45° FOV: 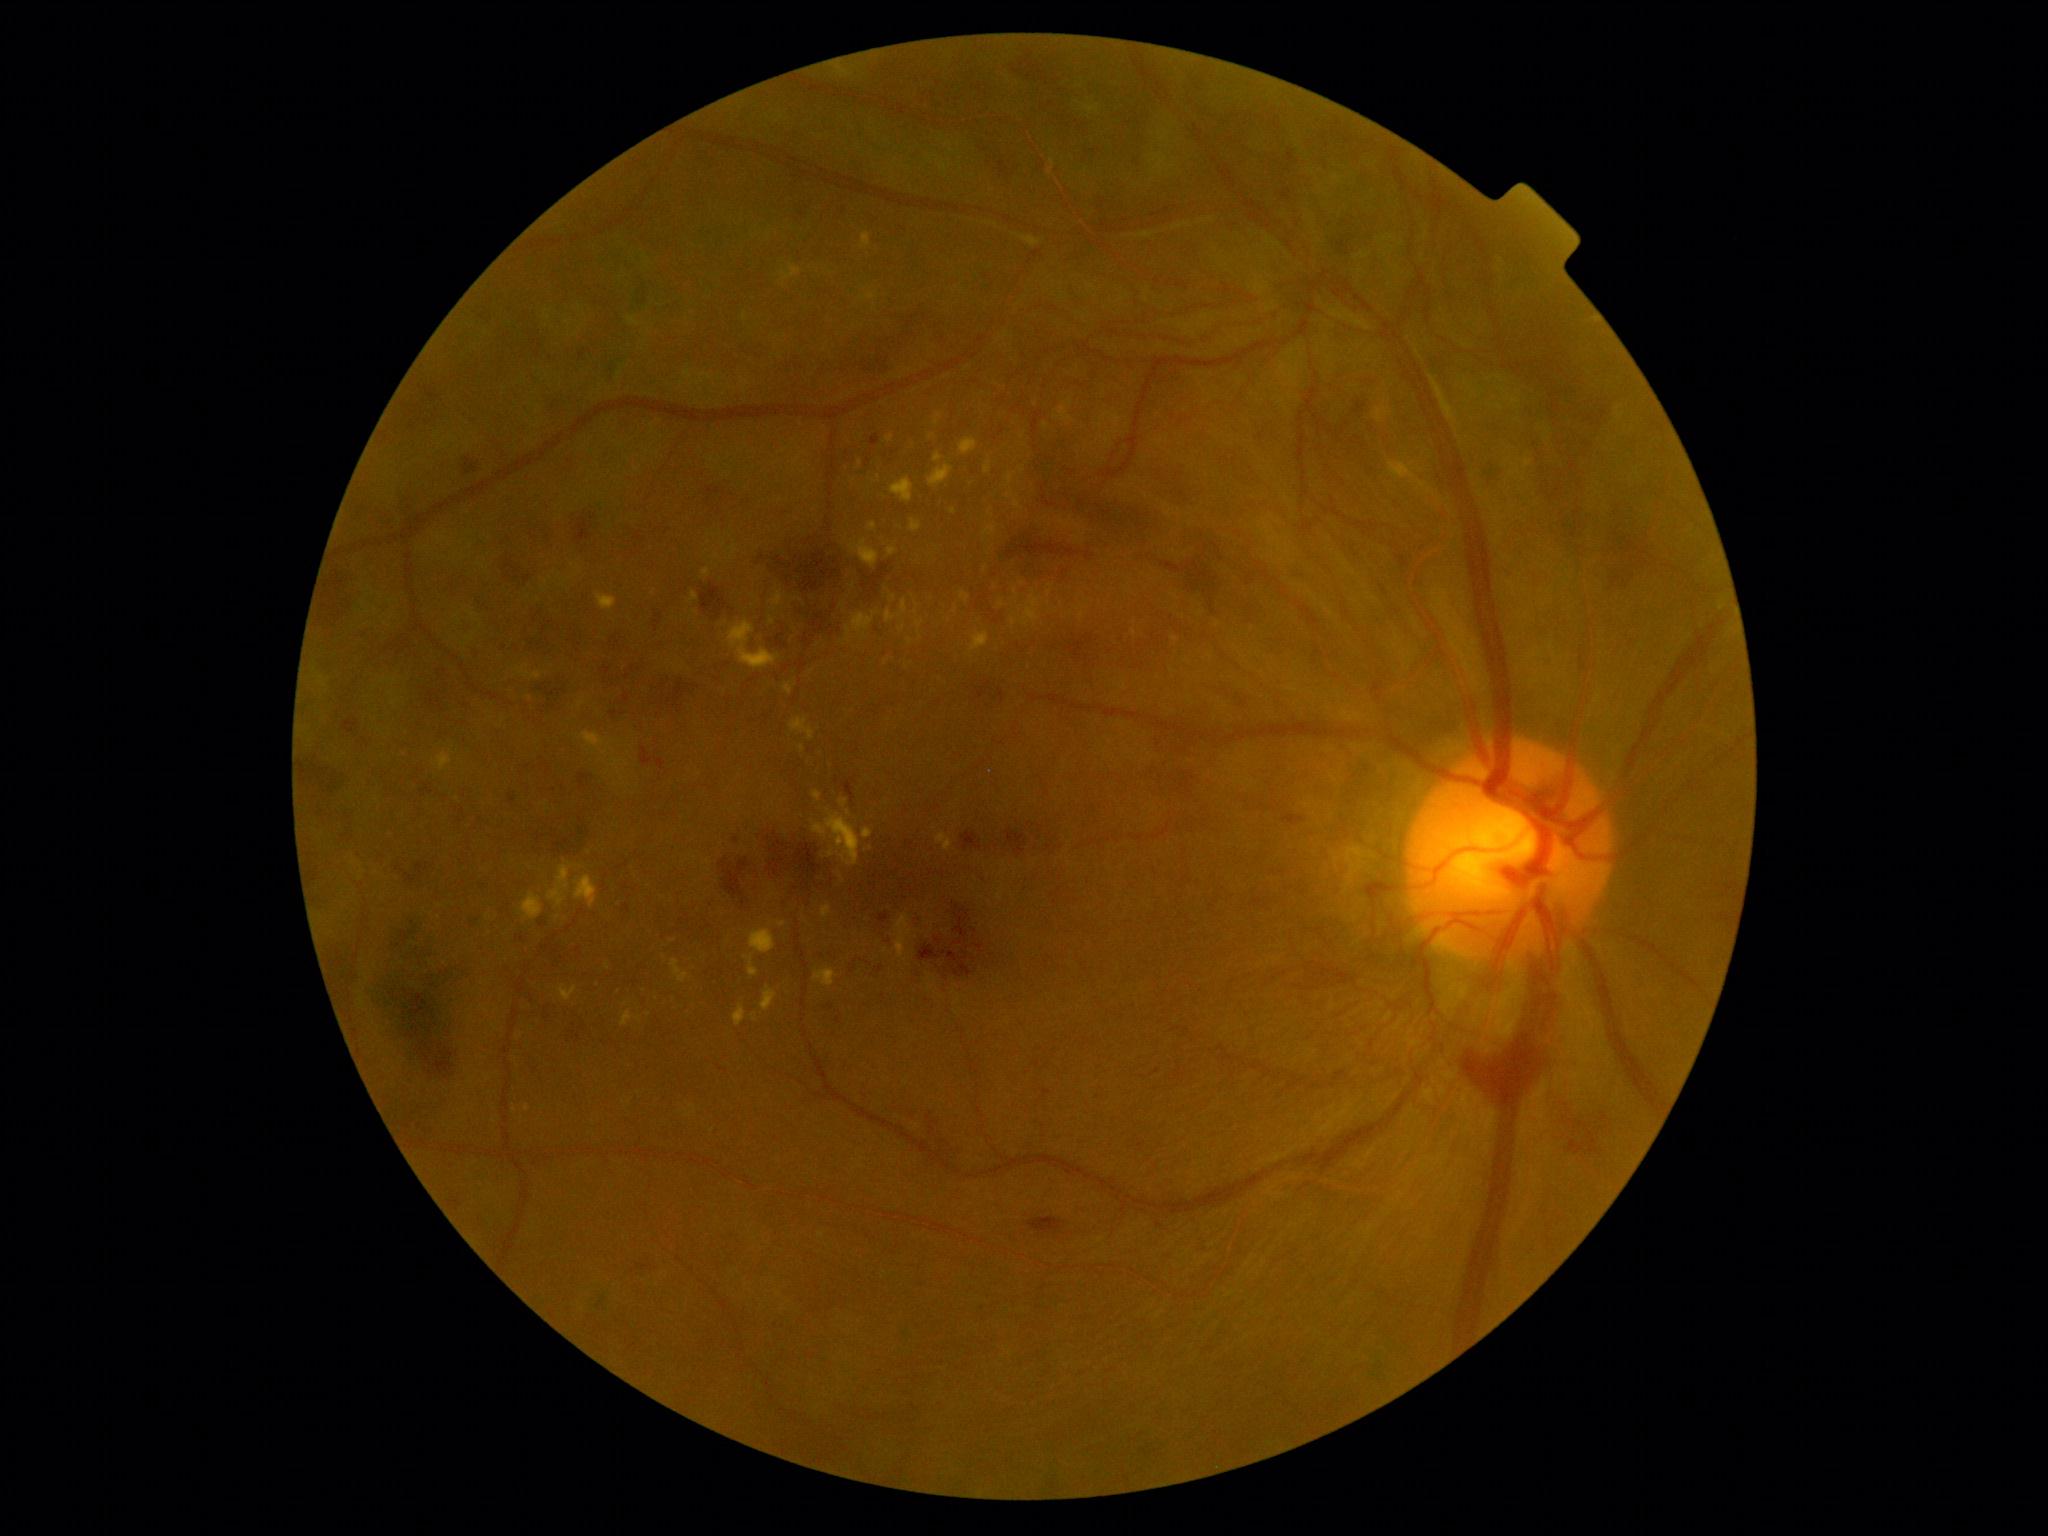

<lesions partial="true">
  <dr_grade>4</dr_grade>
  <ex partial="true">750:929:776:954; 863:828:873:839; 605:962:611:971; 972:631:989:652; 846:810:852:818; 671:959:690:984; 746:954:759:977; 1058:517:1071:530; 628:317:641:327; 933:414:942:425; 886:435:895:443; 548:861:572:908</ex>
  <ex_small_approx>x=530 y=698; x=1016 y=592; x=1135 y=633; x=1077 y=609; x=932 y=437; x=920 y=638; x=649 y=1015; x=893 y=598</ex_small_approx>
  <ma partial="true">578:775:592:789; 509:795:516:805; 590:513:597:521; 878:965:885:974; 343:717:360:736; 870:434:880:447; 835:777:839:785; 472:919:482:928; 992:690:1005:703; 1282:189:1292:201; 1092:149:1101:155; 426:390:439:401</ma>
  <ma_small_approx>x=832 y=1008; x=506 y=648; x=851 y=970</ma_small_approx>
  <he partial="true">763:829:825:888; 701:584:727:619; 1032:447:1161:533; 1153:465:1198:510; 926:1104:955:1160; 1210:683:1251:709; 531:679:572:710; 641:747:665:770; 796:659:807:670; 962:830:982:852; 524:630:554:653; 463:457:481:475; 315:567:357:632; 1163:527:1231:601</he>
</lesions>